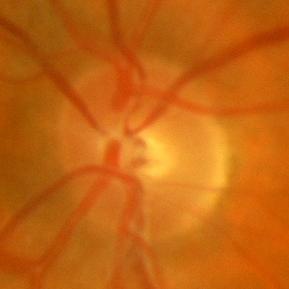
Optic nerve head appearance consistent with no glaucomatous changes.